100° field of view (Phoenix ICON); Phoenix ICON wide-field infant fundus image; 1240 x 1240 pixels.
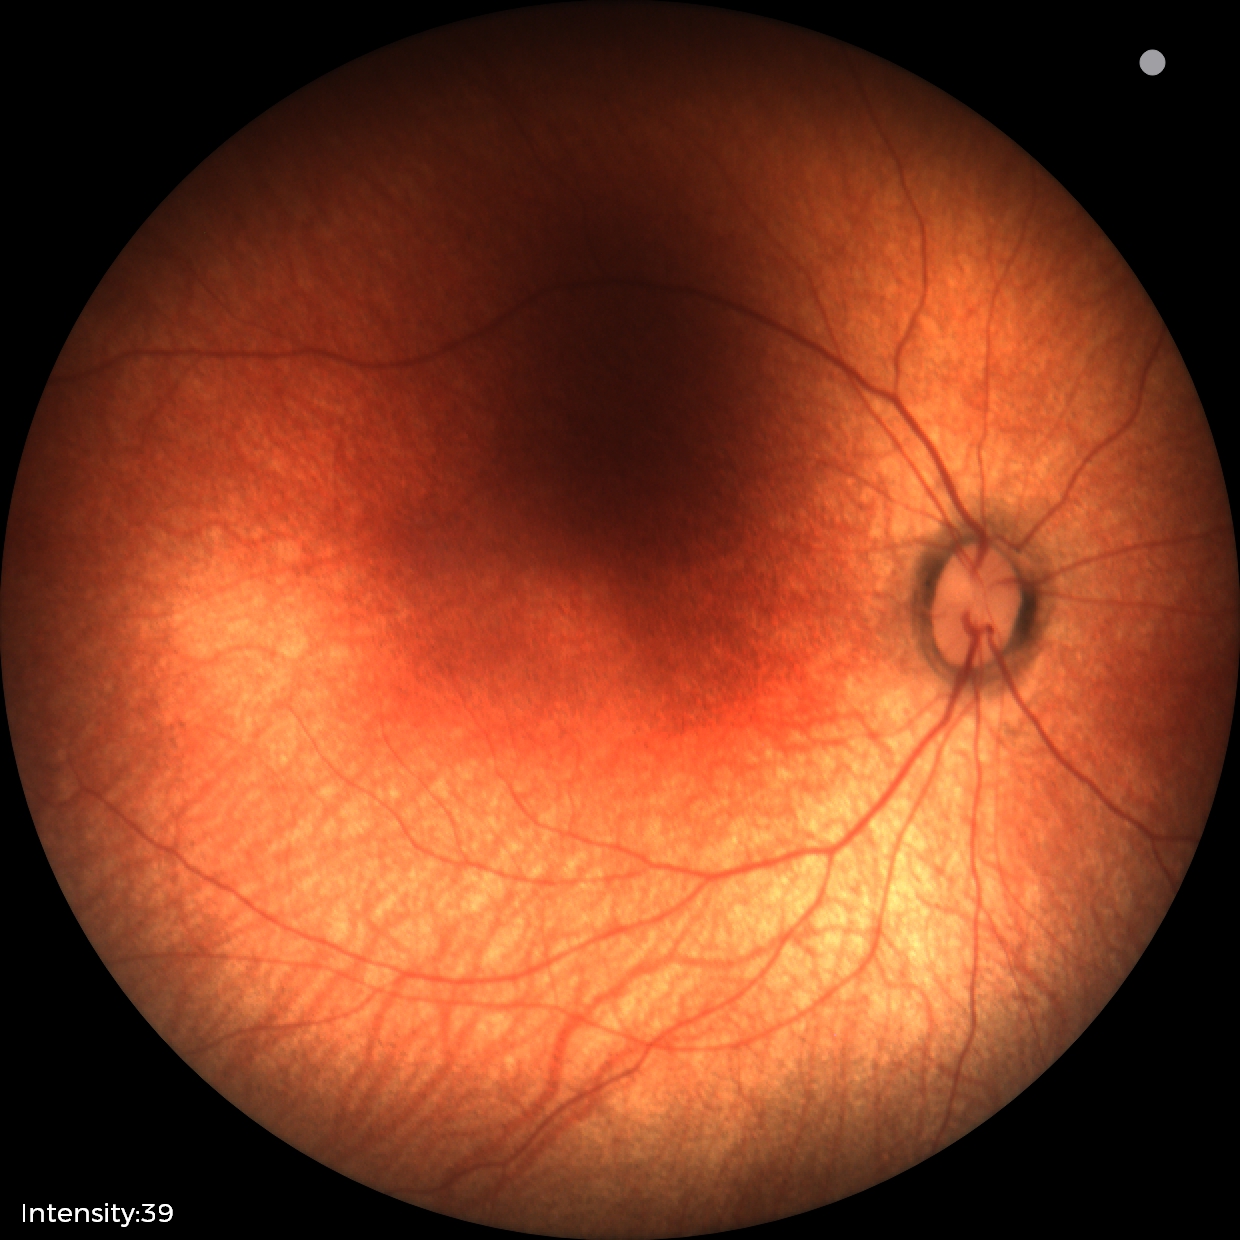

Screening diagnosis: normal fundus examination.